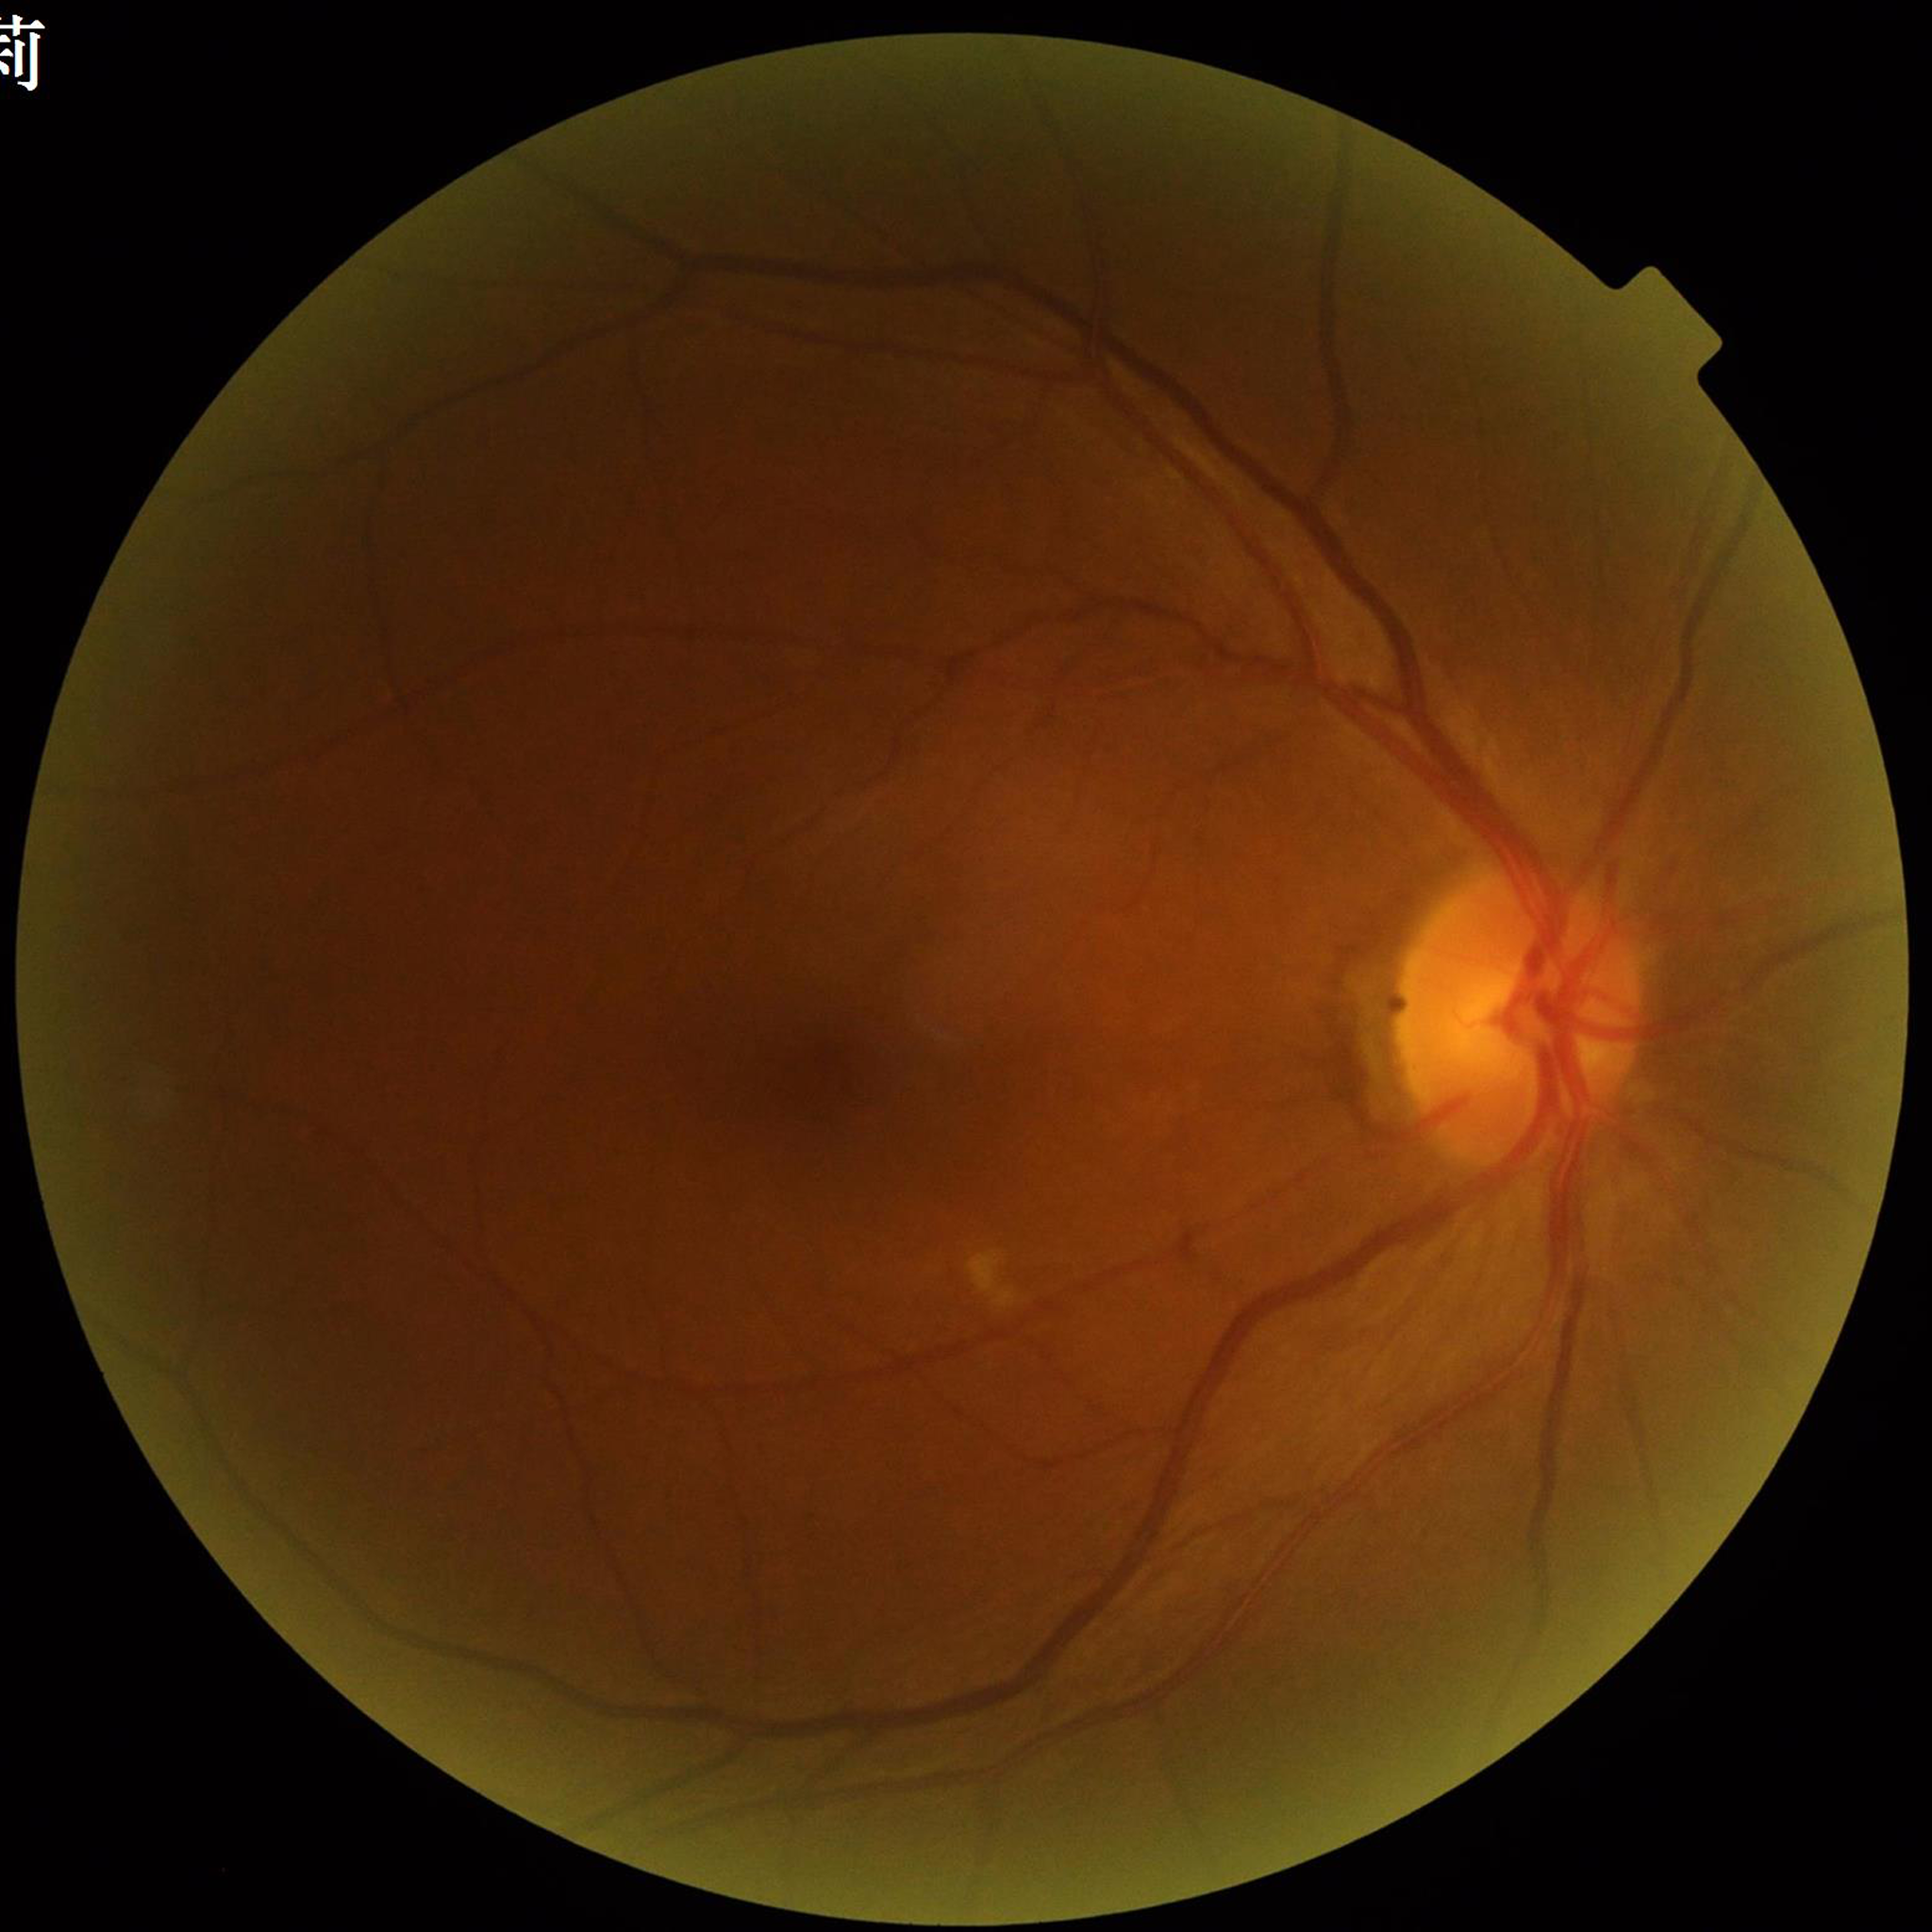 Patient diagnosed with diabetic retinopathy.
Photo quality: poor — illumination/color distortion.